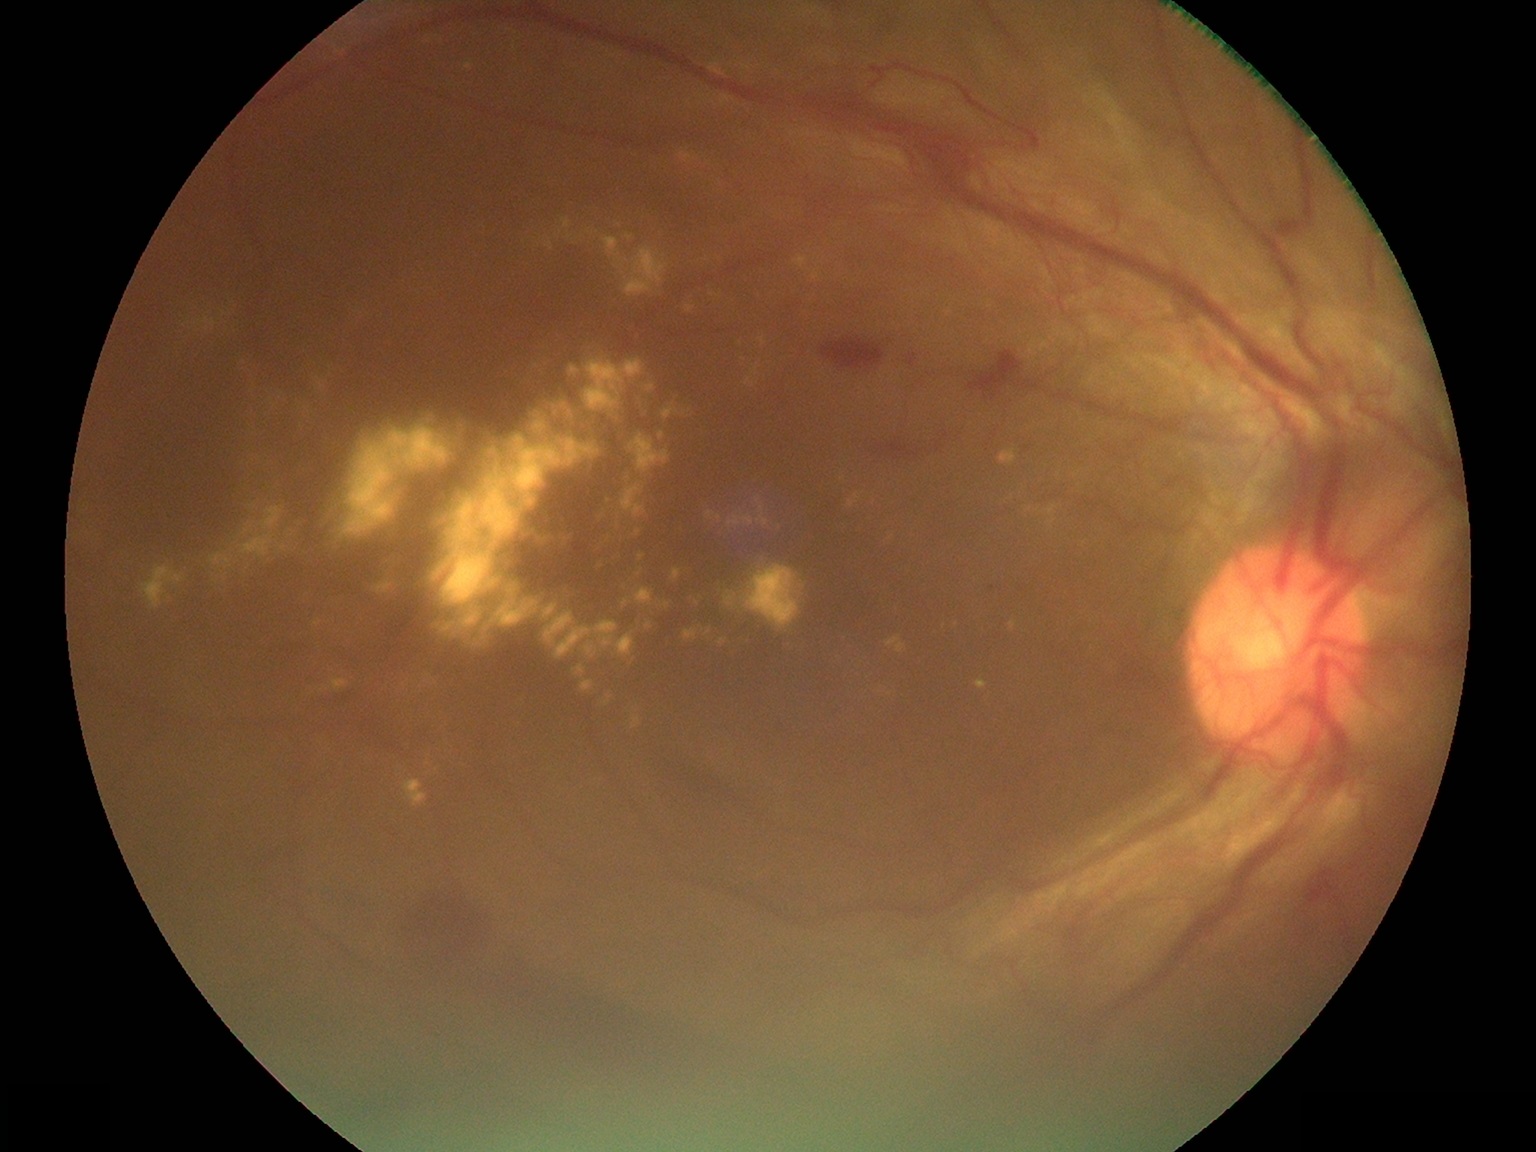
Diabetic retinopathy (DR): 4
Lesions identified (partial list):
hard exudates (EXs) (partial) = (left=629, top=528, right=643, bottom=538), (left=658, top=432, right=665, bottom=440), (left=756, top=495, right=769, bottom=527), (left=465, top=62, right=475, bottom=72), (left=533, top=420, right=548, bottom=435), (left=808, top=269, right=823, bottom=281), (left=606, top=535, right=613, bottom=544), (left=621, top=482, right=647, bottom=520), (left=492, top=600, right=620, bottom=661), (left=659, top=601, right=672, bottom=610), (left=508, top=588, right=516, bottom=599), (left=999, top=449, right=1017, bottom=466)
Smaller EXs around <pt>1028,510</pt>, <pt>233,551</pt>, <pt>844,478</pt>, <pt>421,687</pt>, <pt>539,245</pt>, <pt>707,260</pt>